Modified Davis grading: 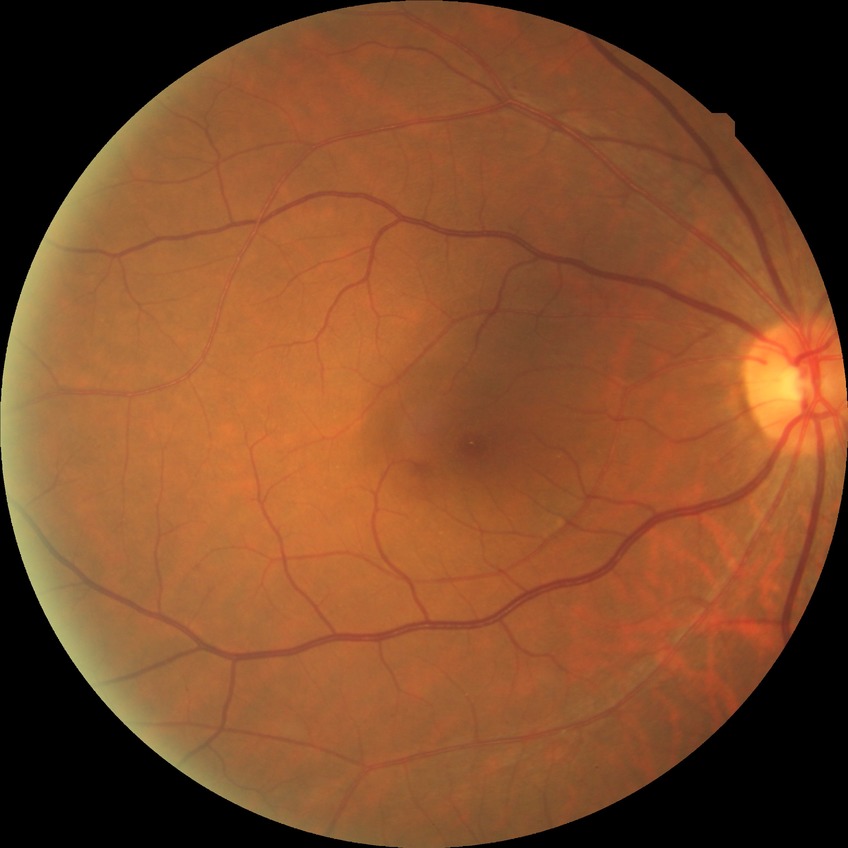
Diabetic retinopathy (DR) is no diabetic retinopathy (NDR).